45-degree field of view. 848 x 848 pixels: 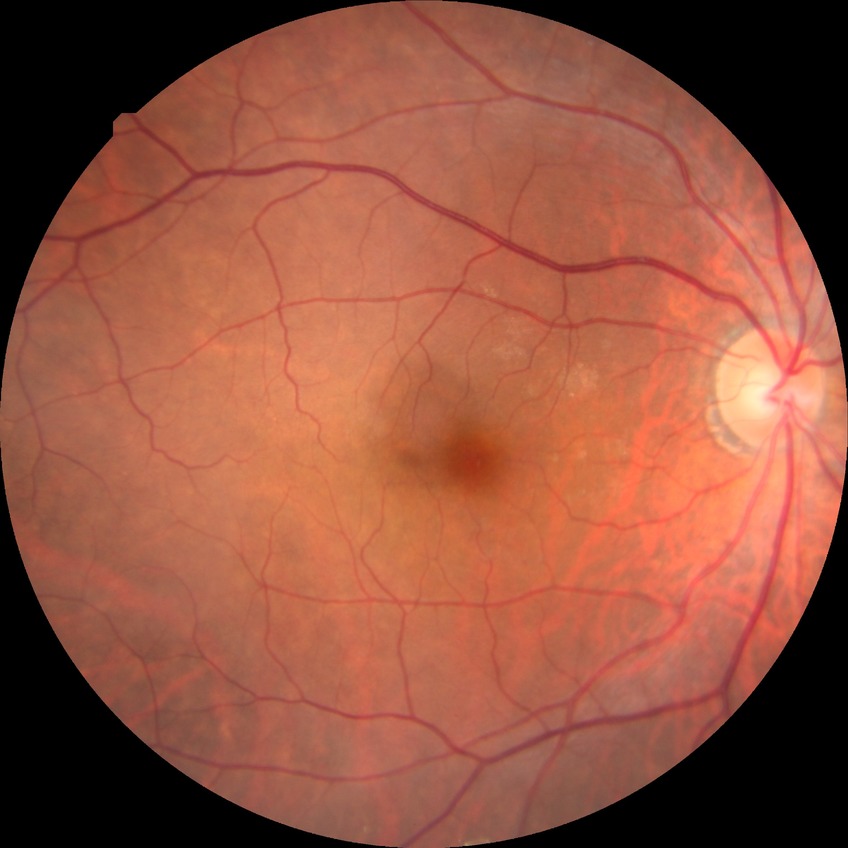
diabetic retinopathy (DR): simple diabetic retinopathy (SDR)